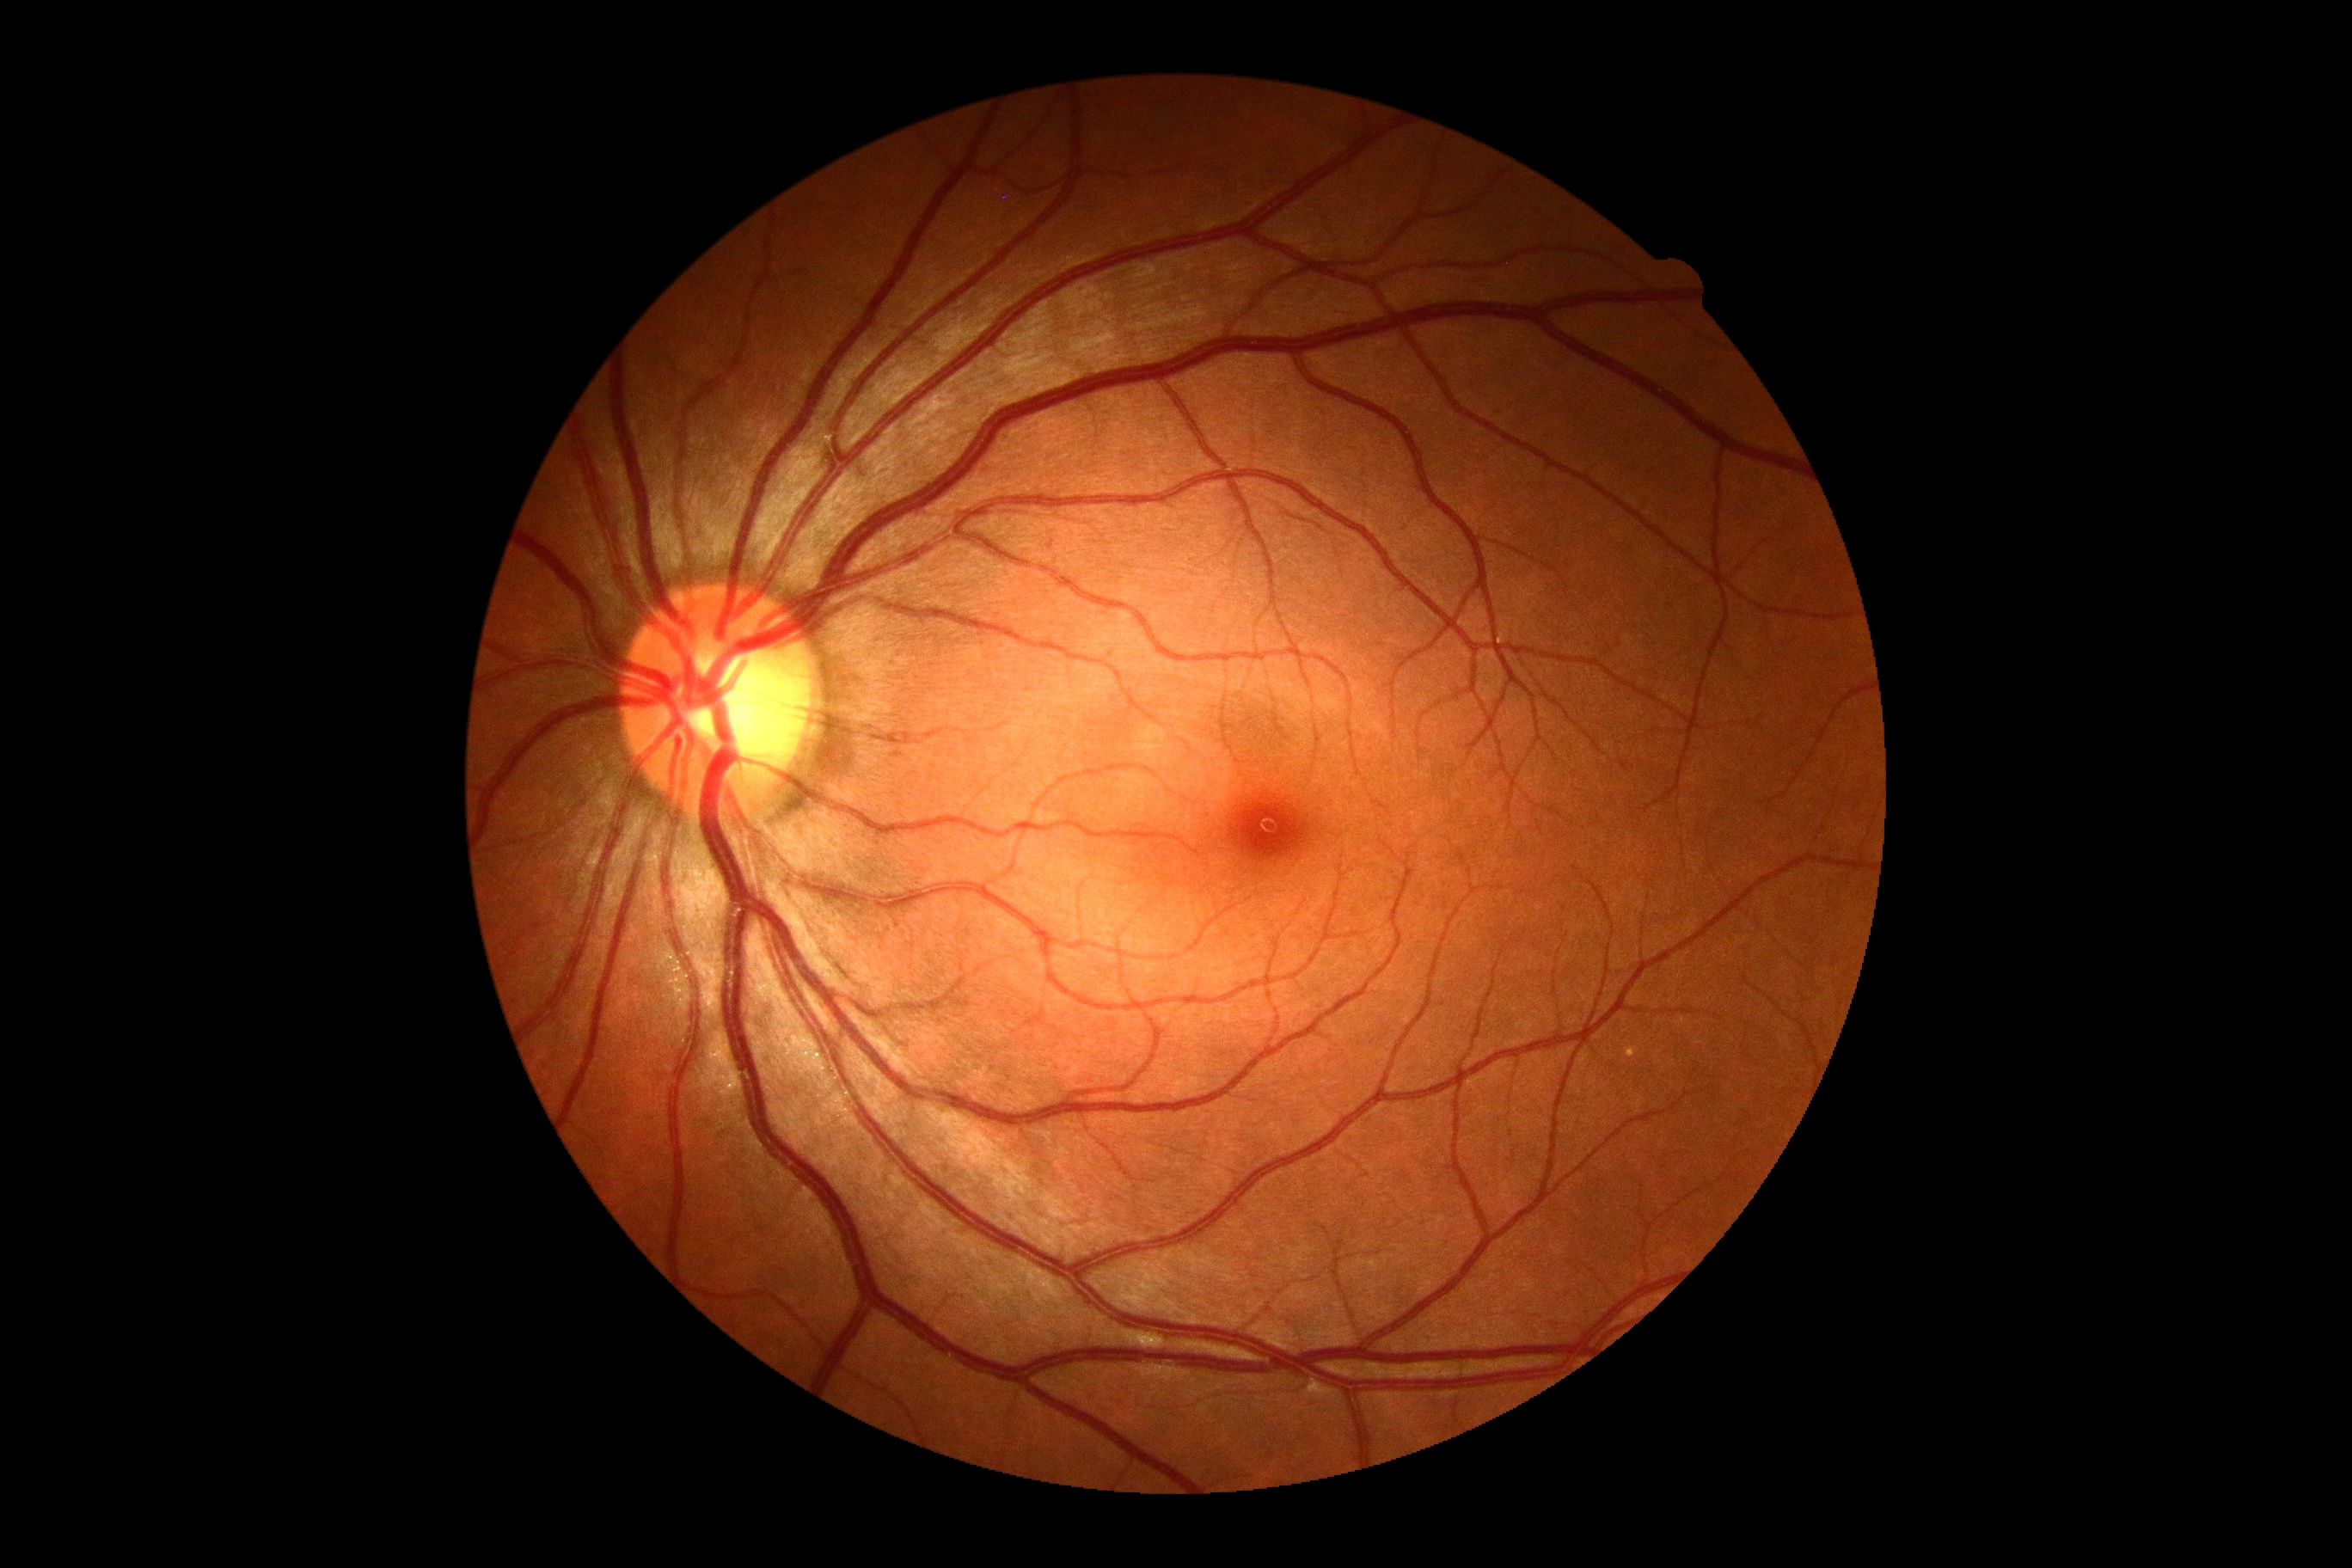 Diabetic retinopathy severity is grade 0 (no apparent retinopathy).